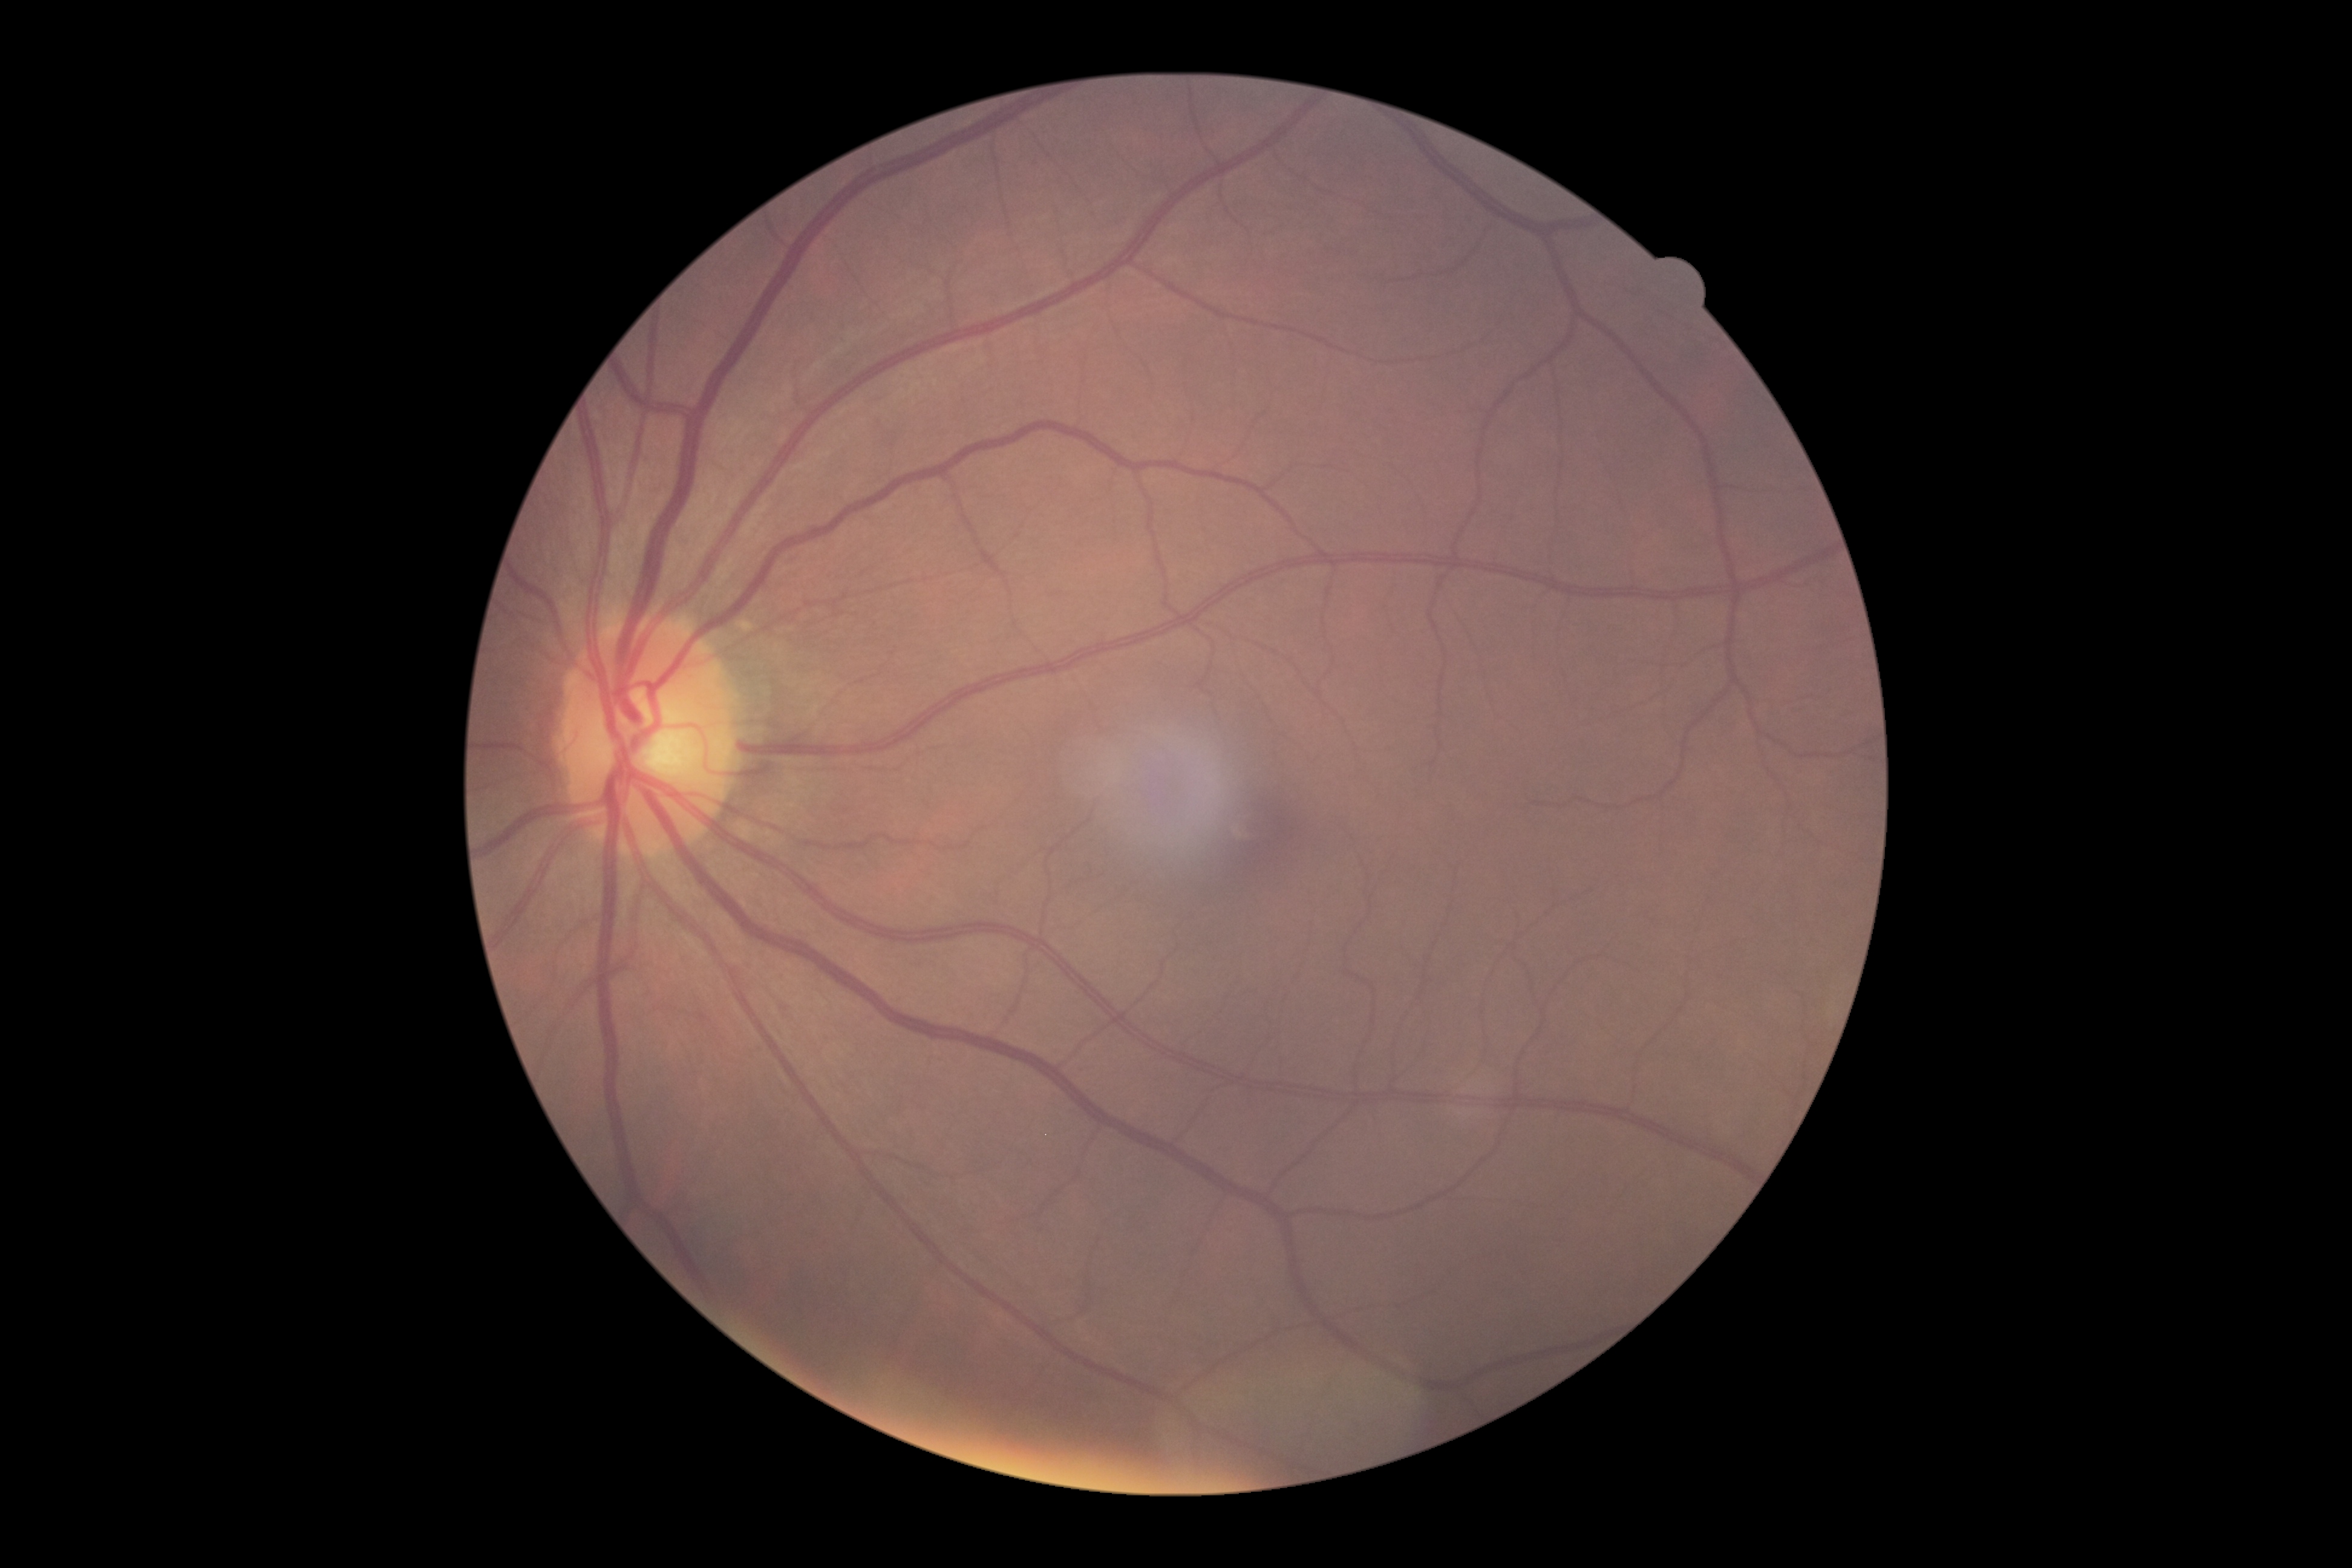

Diabetic retinopathy (DR): grade 0 — no visible signs of diabetic retinopathy.